Phoenix ICON wide-field infant fundus image — 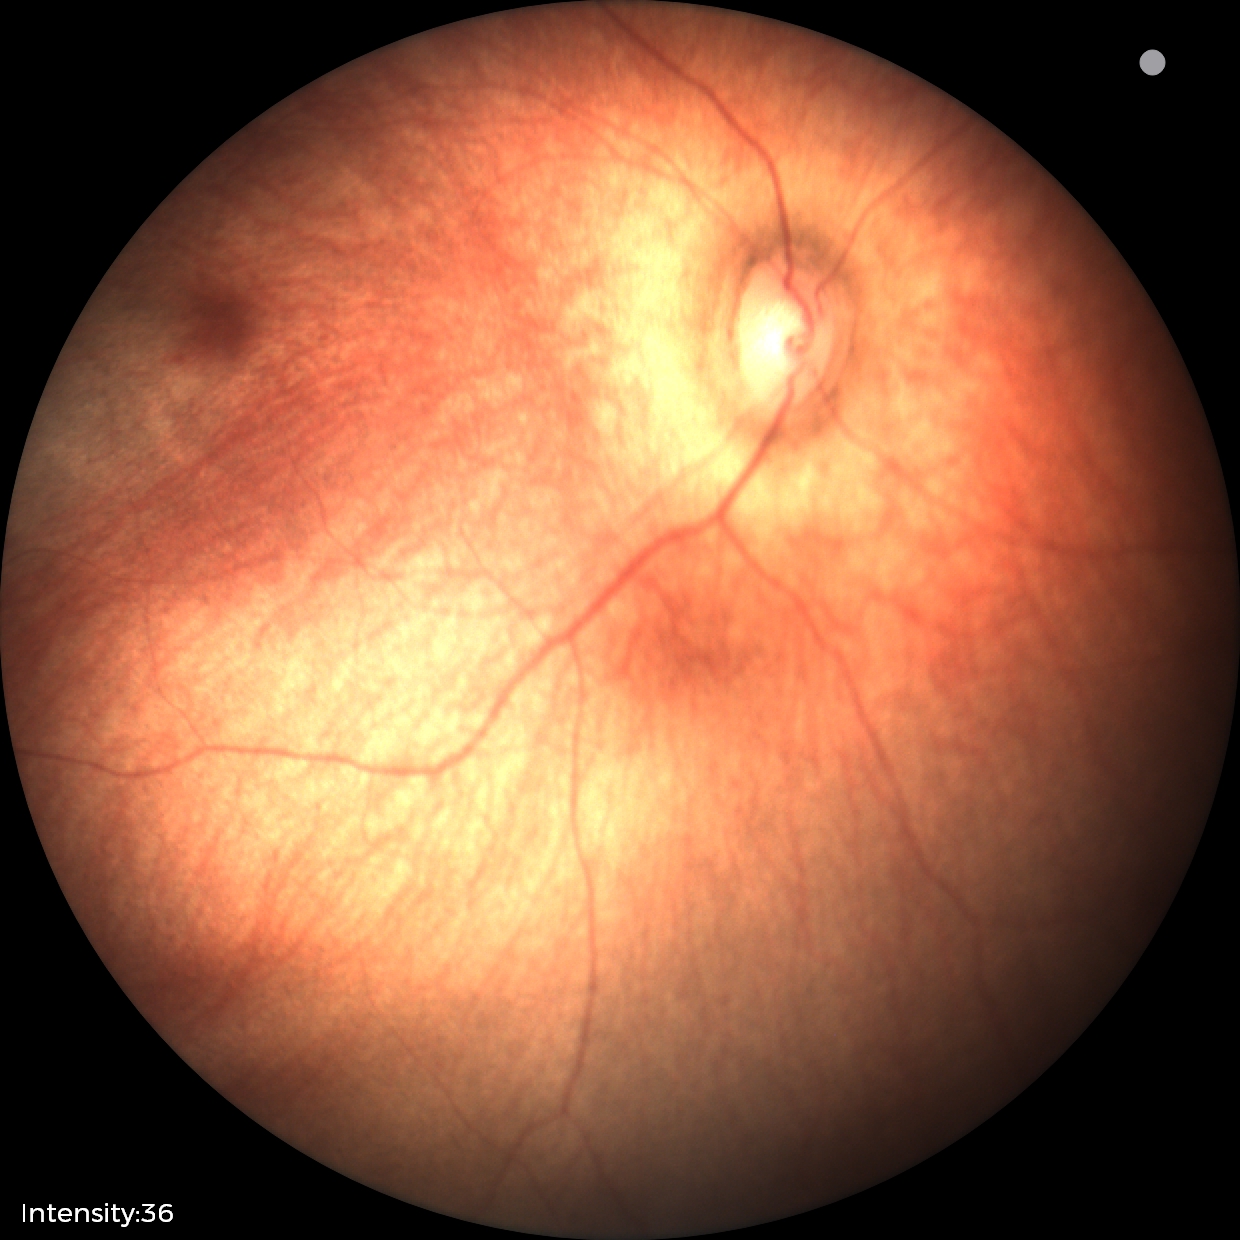

No retinal pathology identified on screening.